Fundus photo.
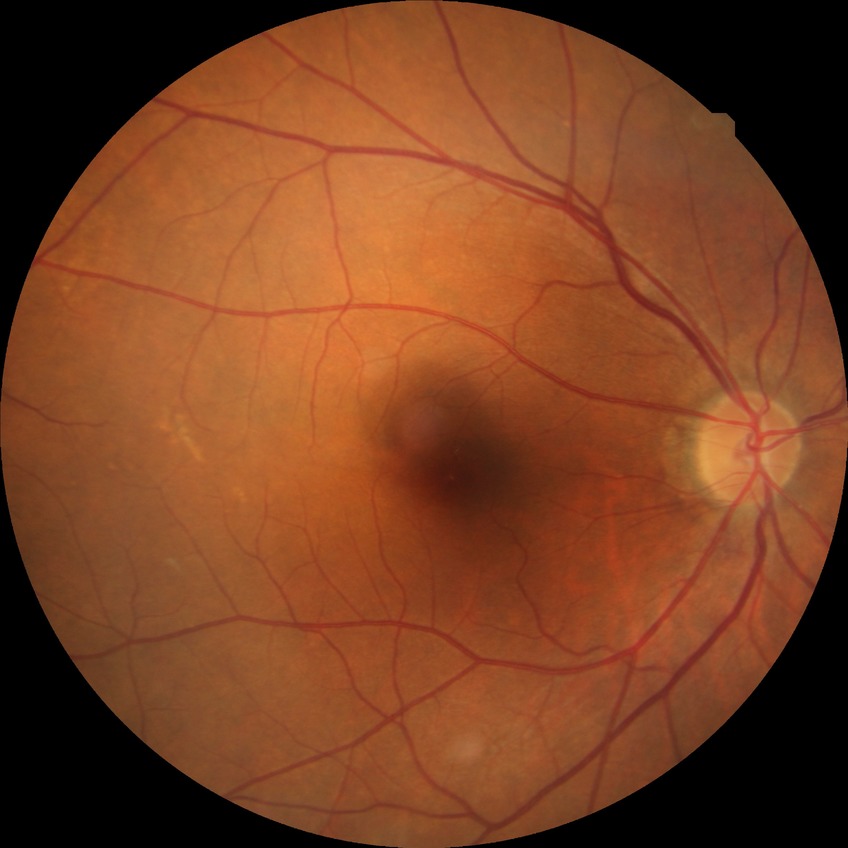 Diabetic retinopathy (DR): NDR (no diabetic retinopathy).